Phoenix ICON wide-field infant fundus image — 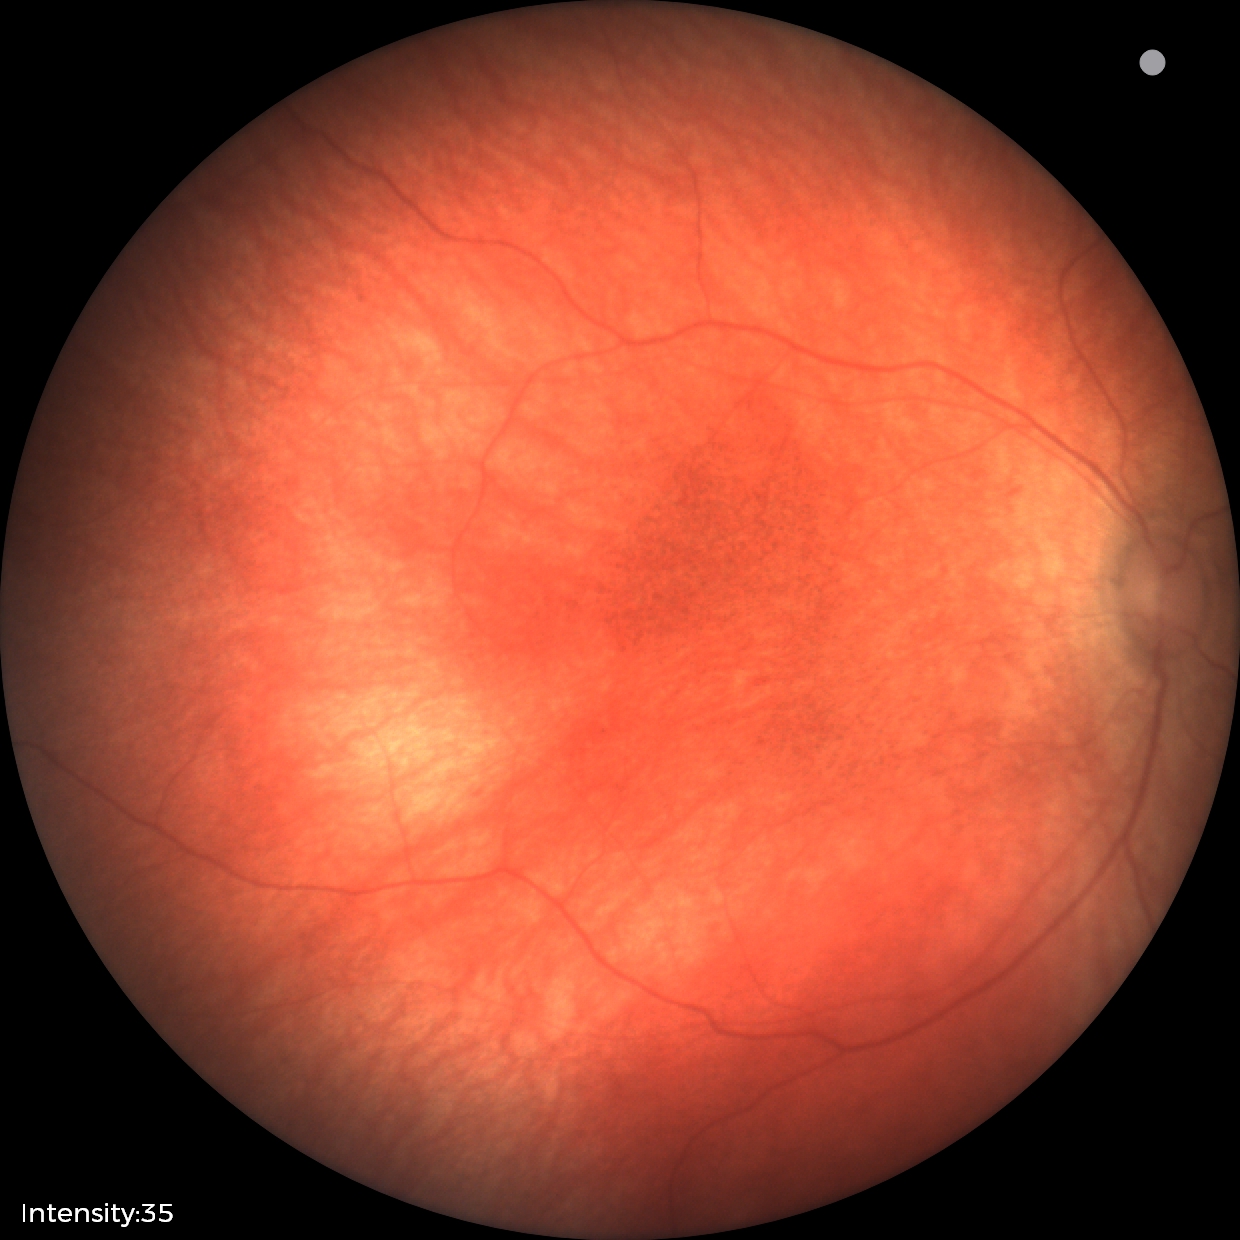

No retinal pathology identified on screening.